Cropped to the optic nerve head · 240x240.
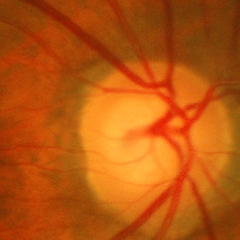

No glaucoma.